Camera: Natus RetCam Envision (130° FOV). Wide-field fundus photograph of an infant. Image size 1440x1080:
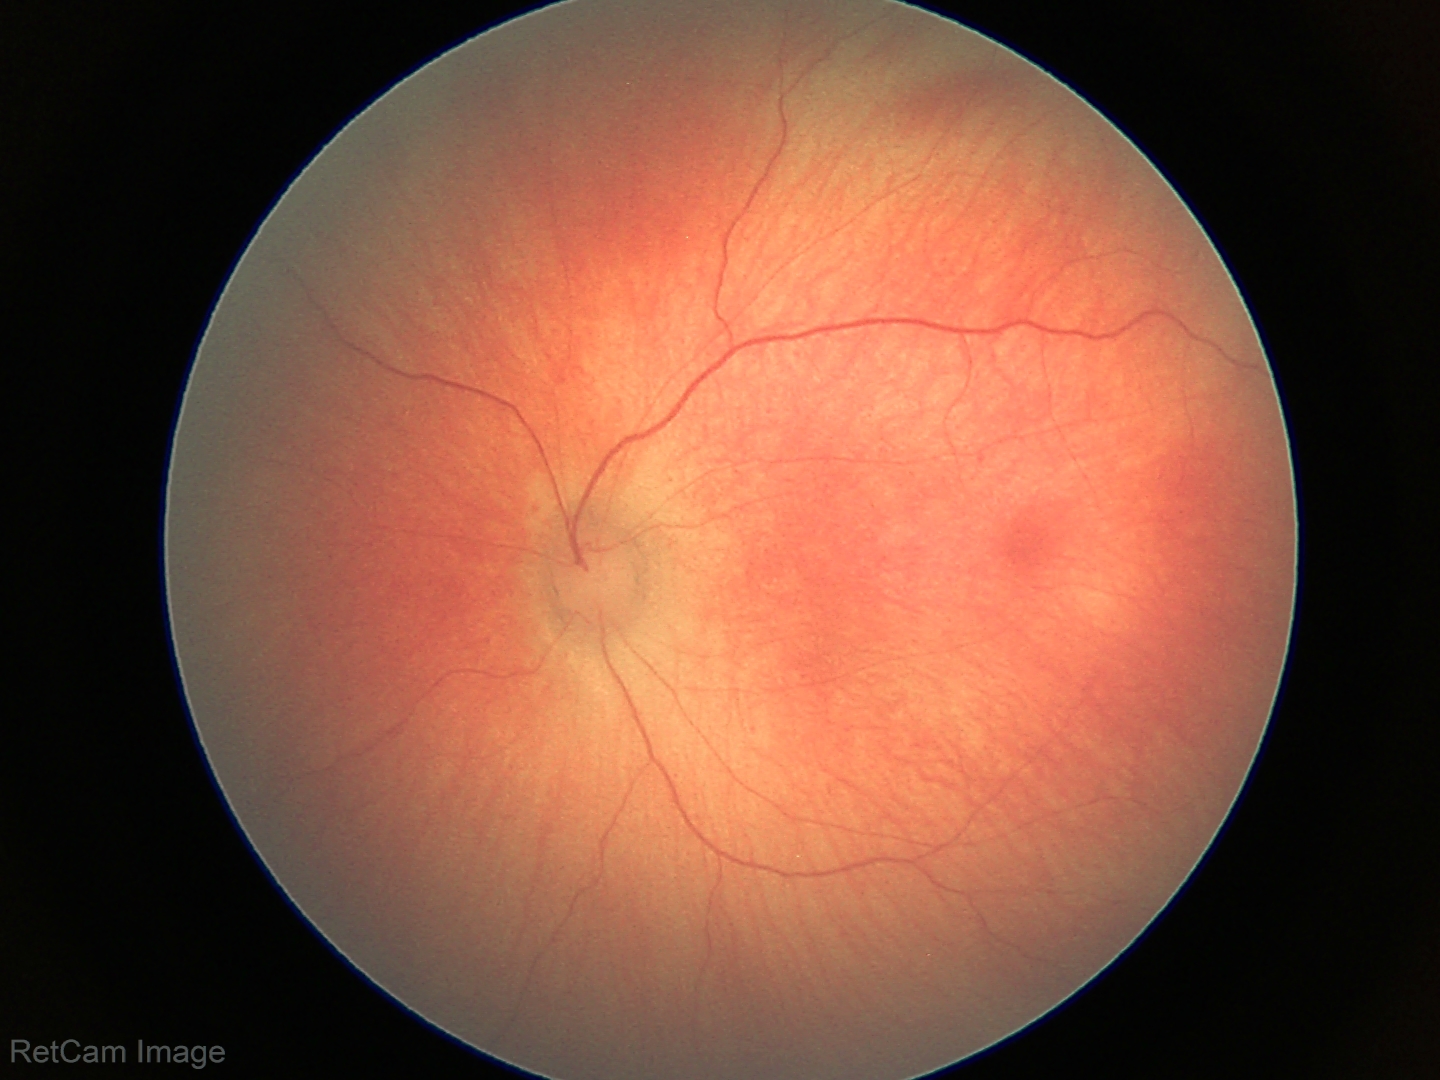
From an examination with diagnosis of retinal hemorrhages.